Fundus photo taken with a portable handheld camera · 60° FOV:
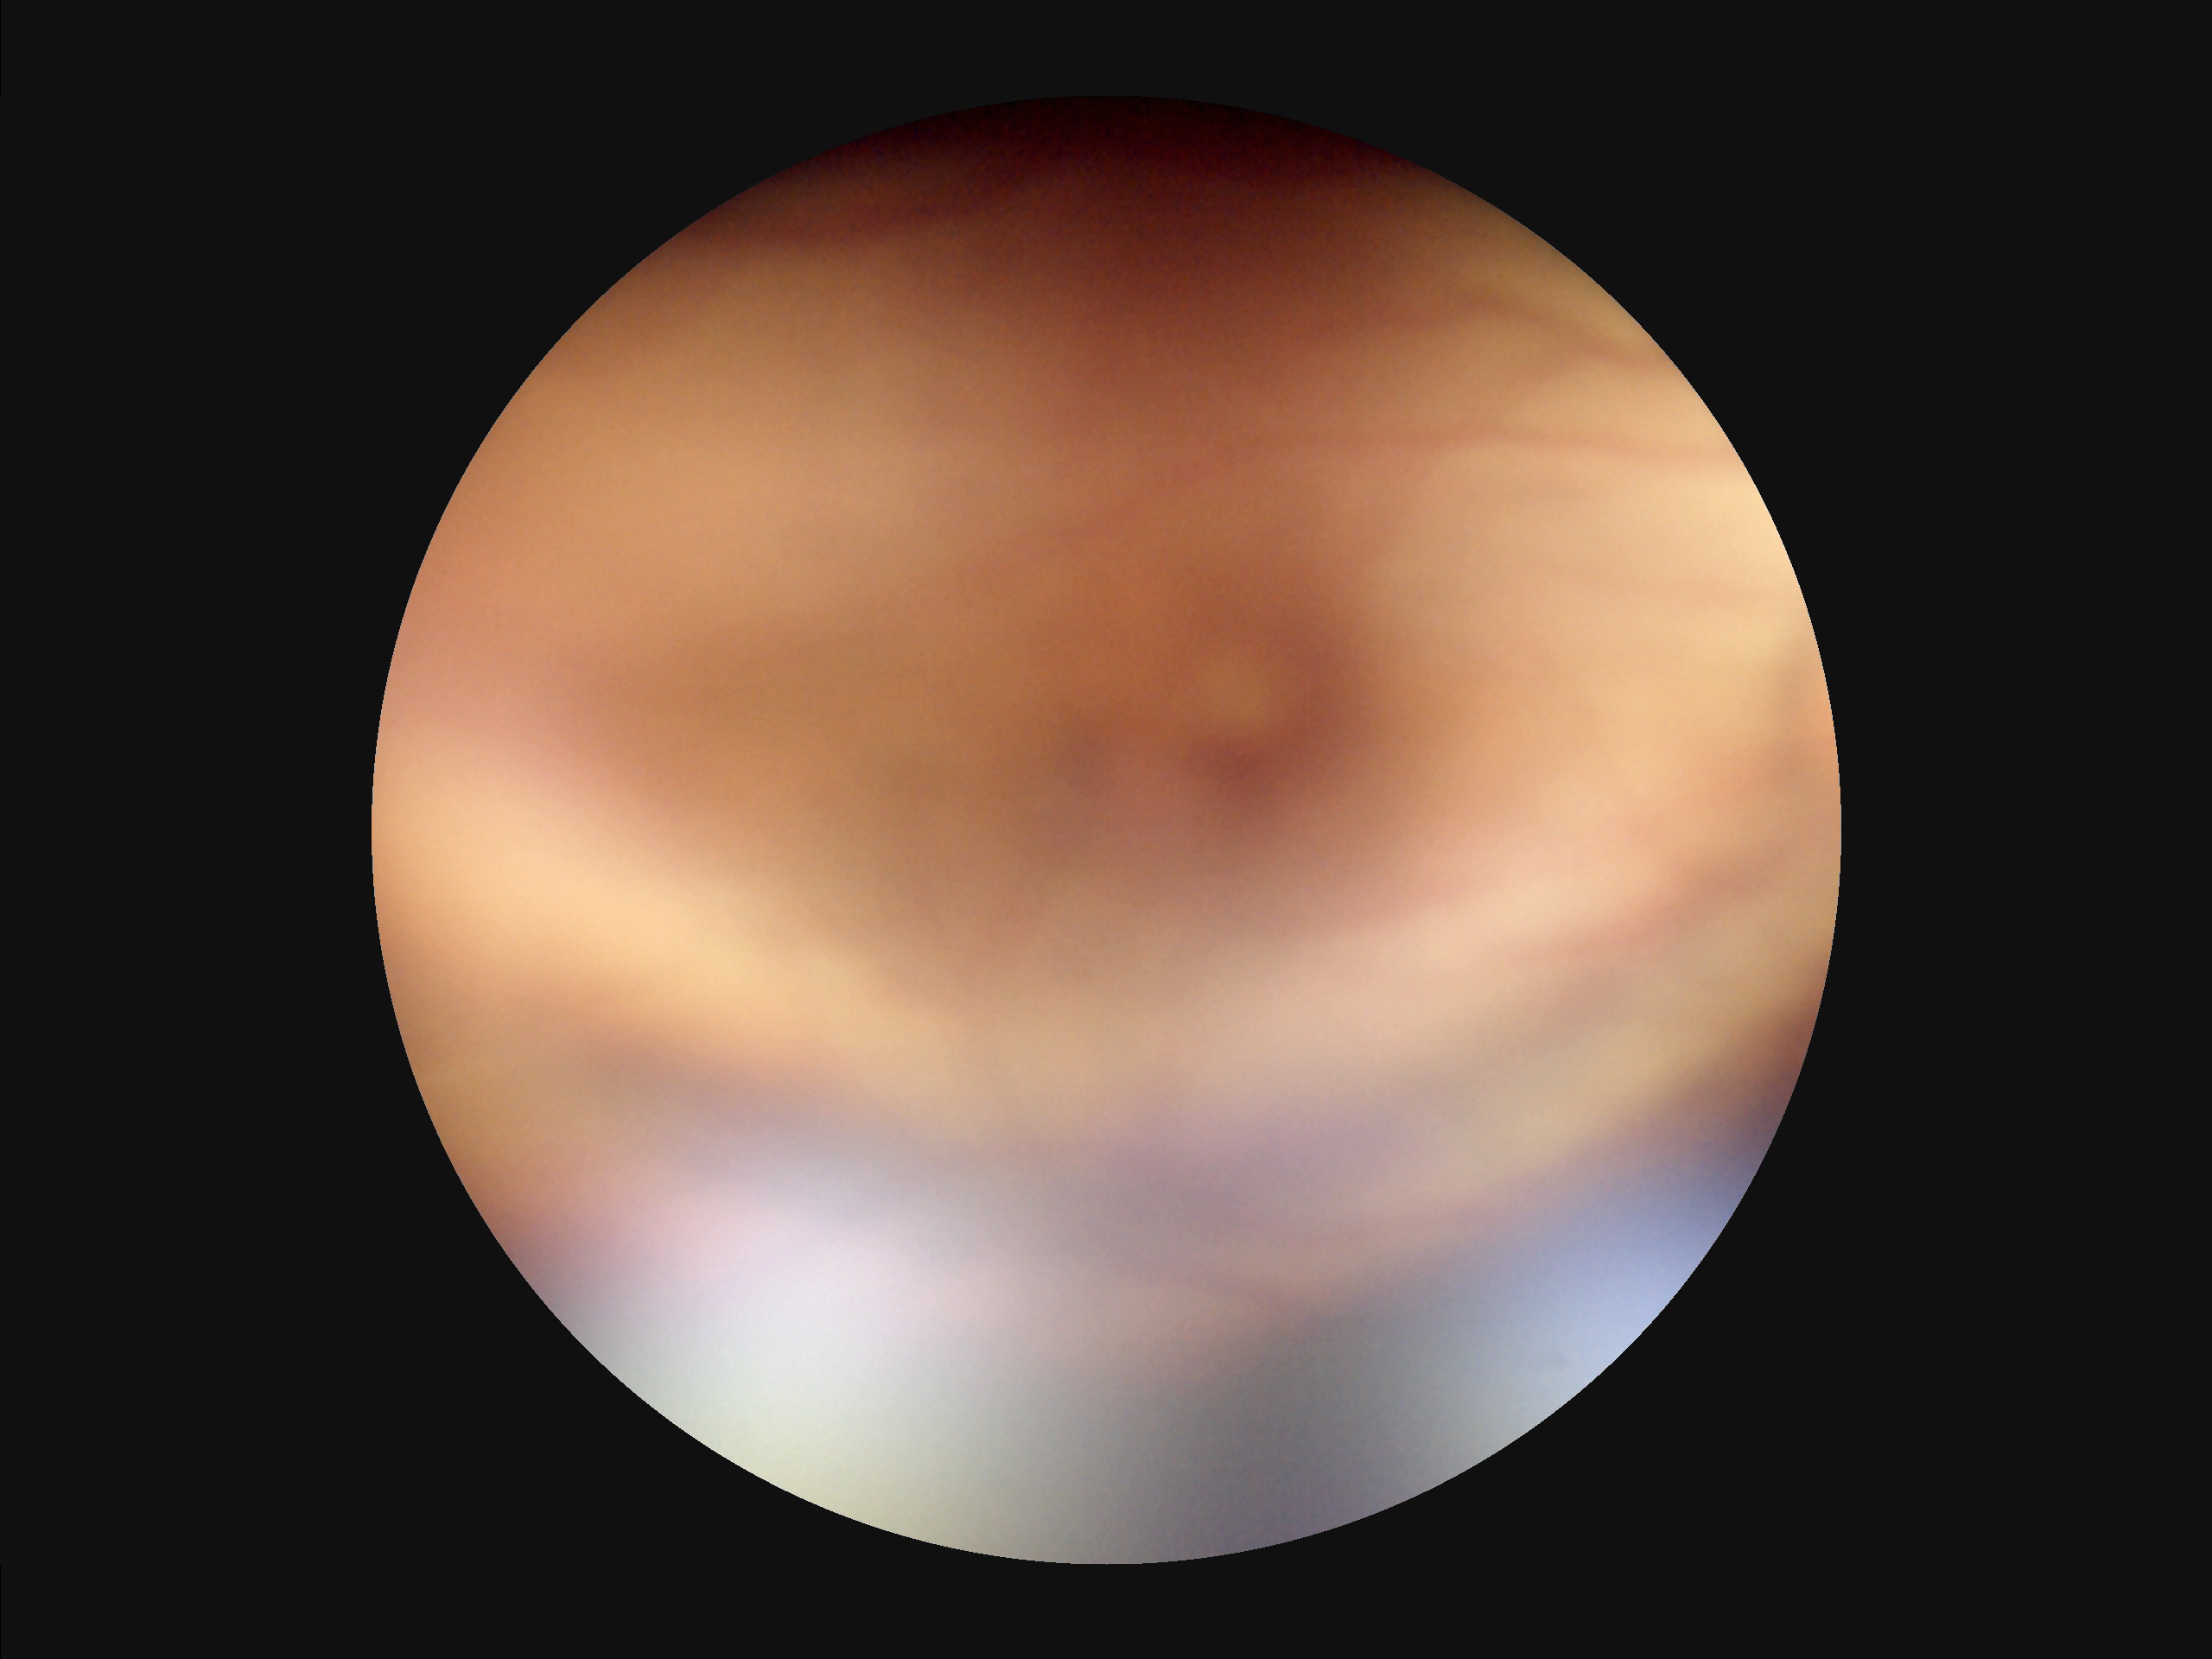

Poor illumination with uneven exposure. Overall quality is poor; the image is difficult to grade. Out of focus; structures are indistinct. Poor dynamic range.